RetCam wide-field infant fundus image · 640x480 — 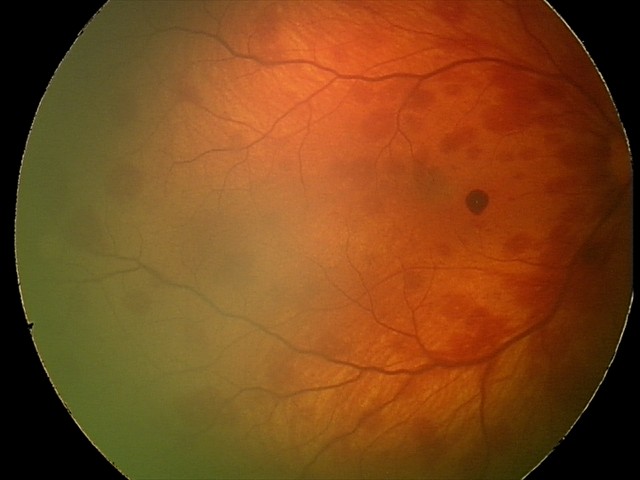

Assessment: retinal hemorrhages.